Acquired on the Clarity RetCam 3; 640 x 480 pixels; pediatric retinal photograph (wide-field).
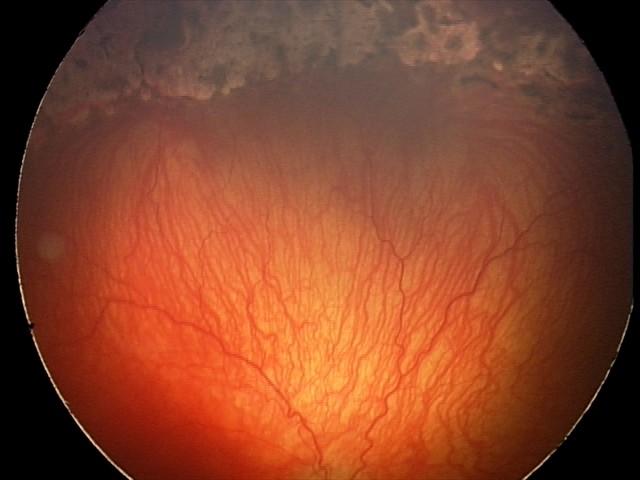 Diagnosis from this screening exam: aggressive retinopathy of prematurity — rapidly progressive severe ROP with prominent plus disease, often without classic stage progression.